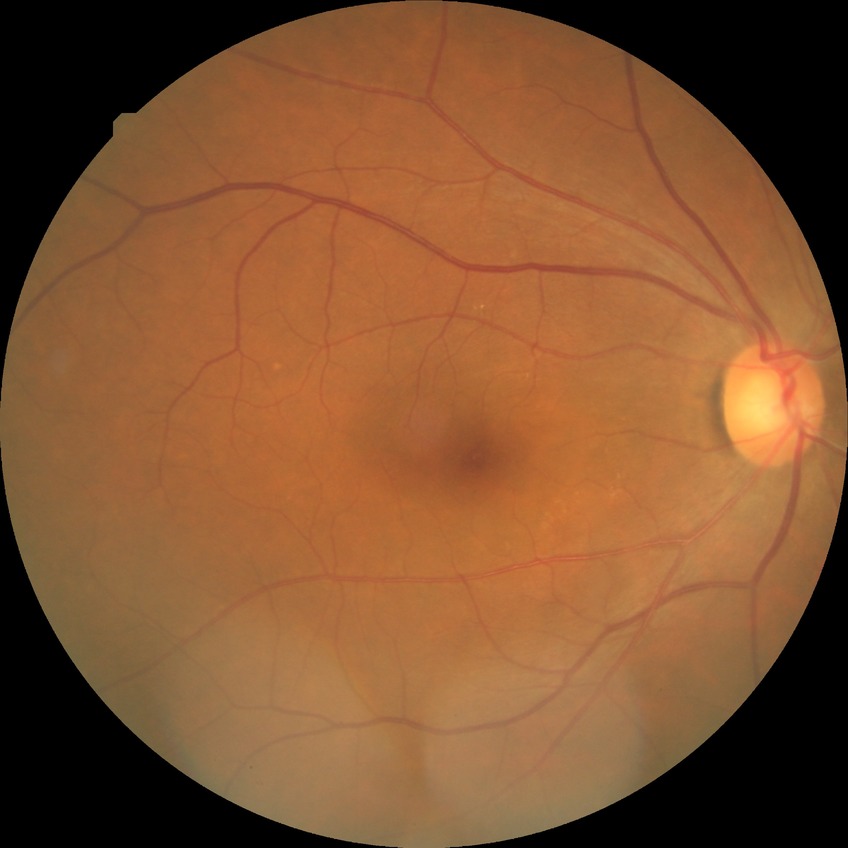 Diabetic retinopathy (DR) is NDR (no diabetic retinopathy).